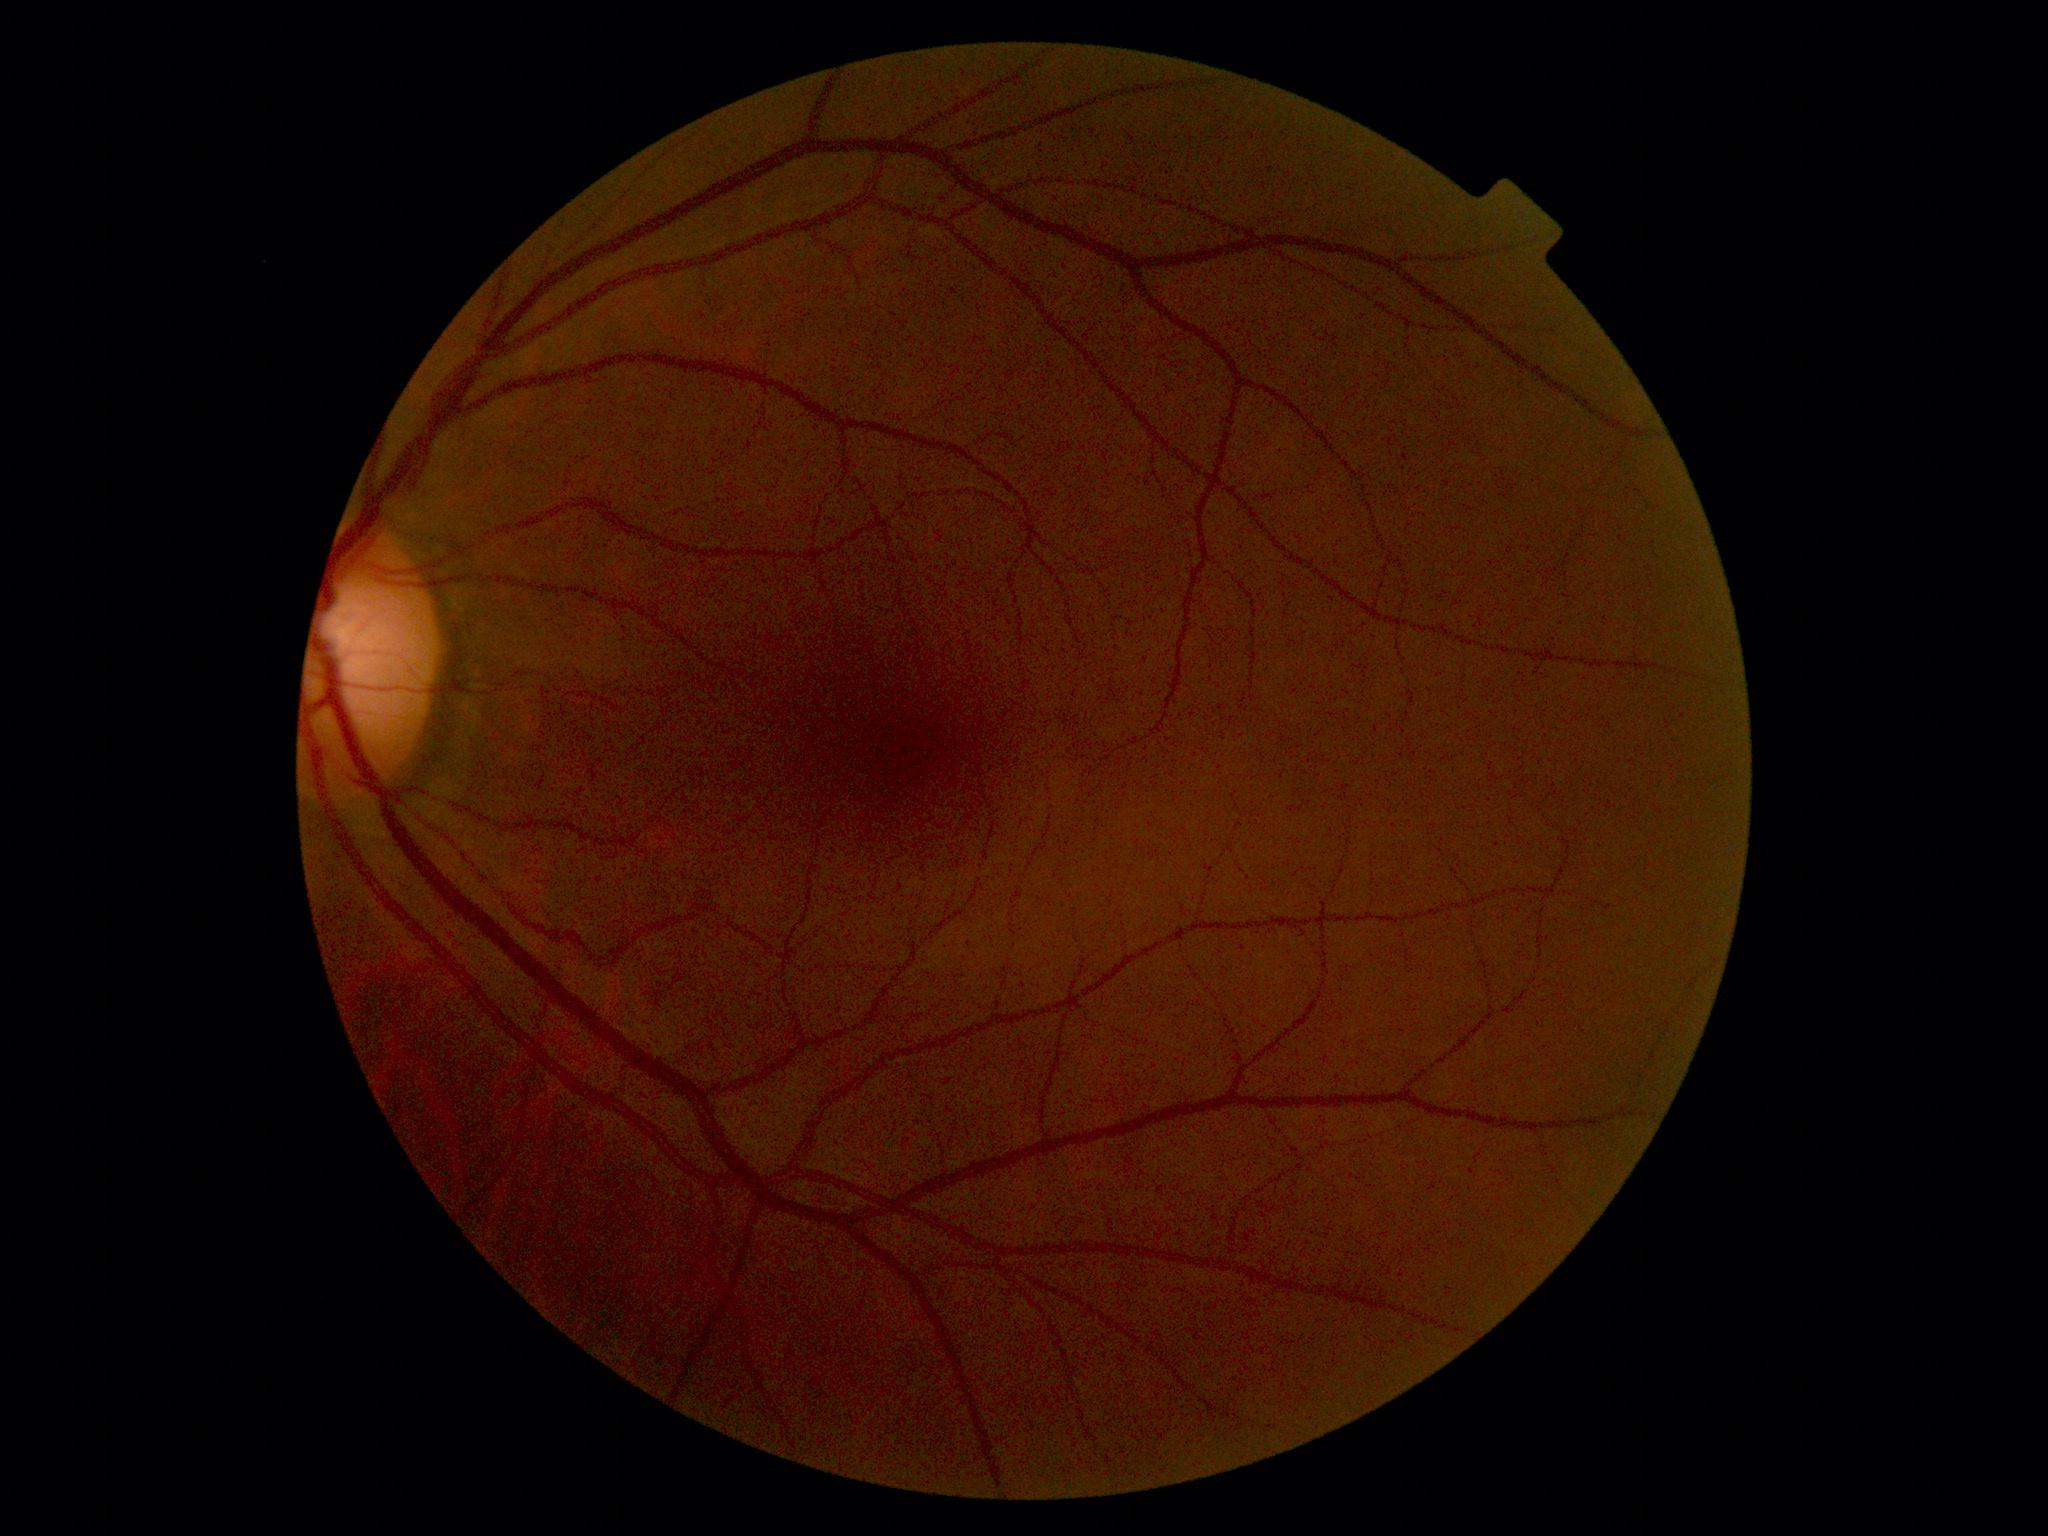

dr_grade: 0
dr_impression: no DR findings